848 by 848 pixels, 45 degree fundus photograph, without pupil dilation — 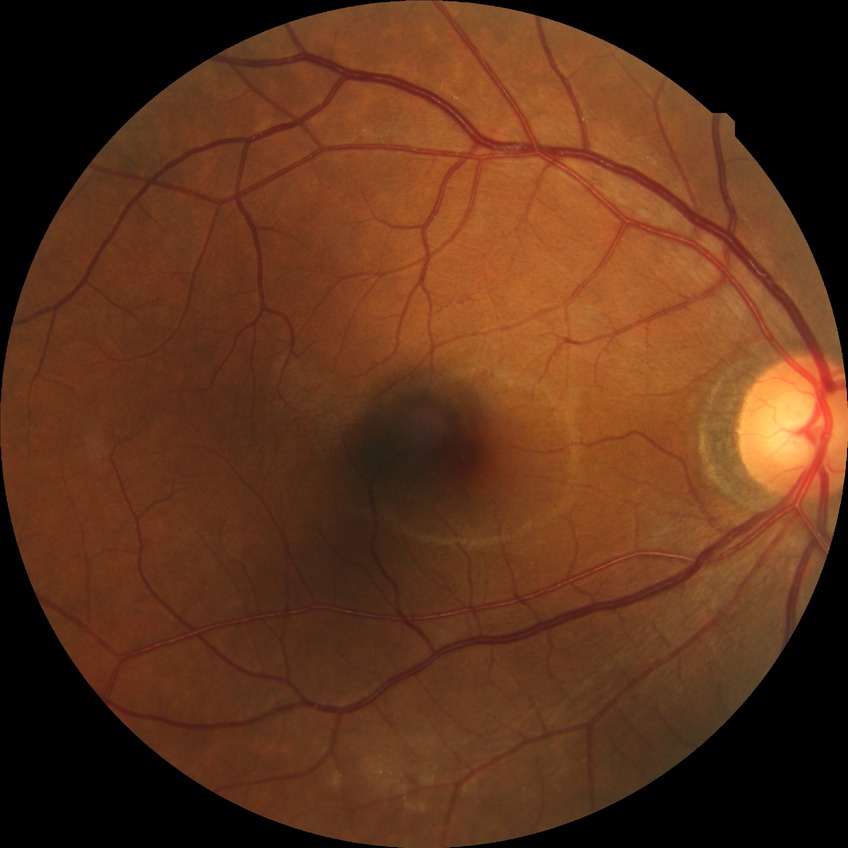
{
  "davis_grade": "no diabetic retinopathy"
}